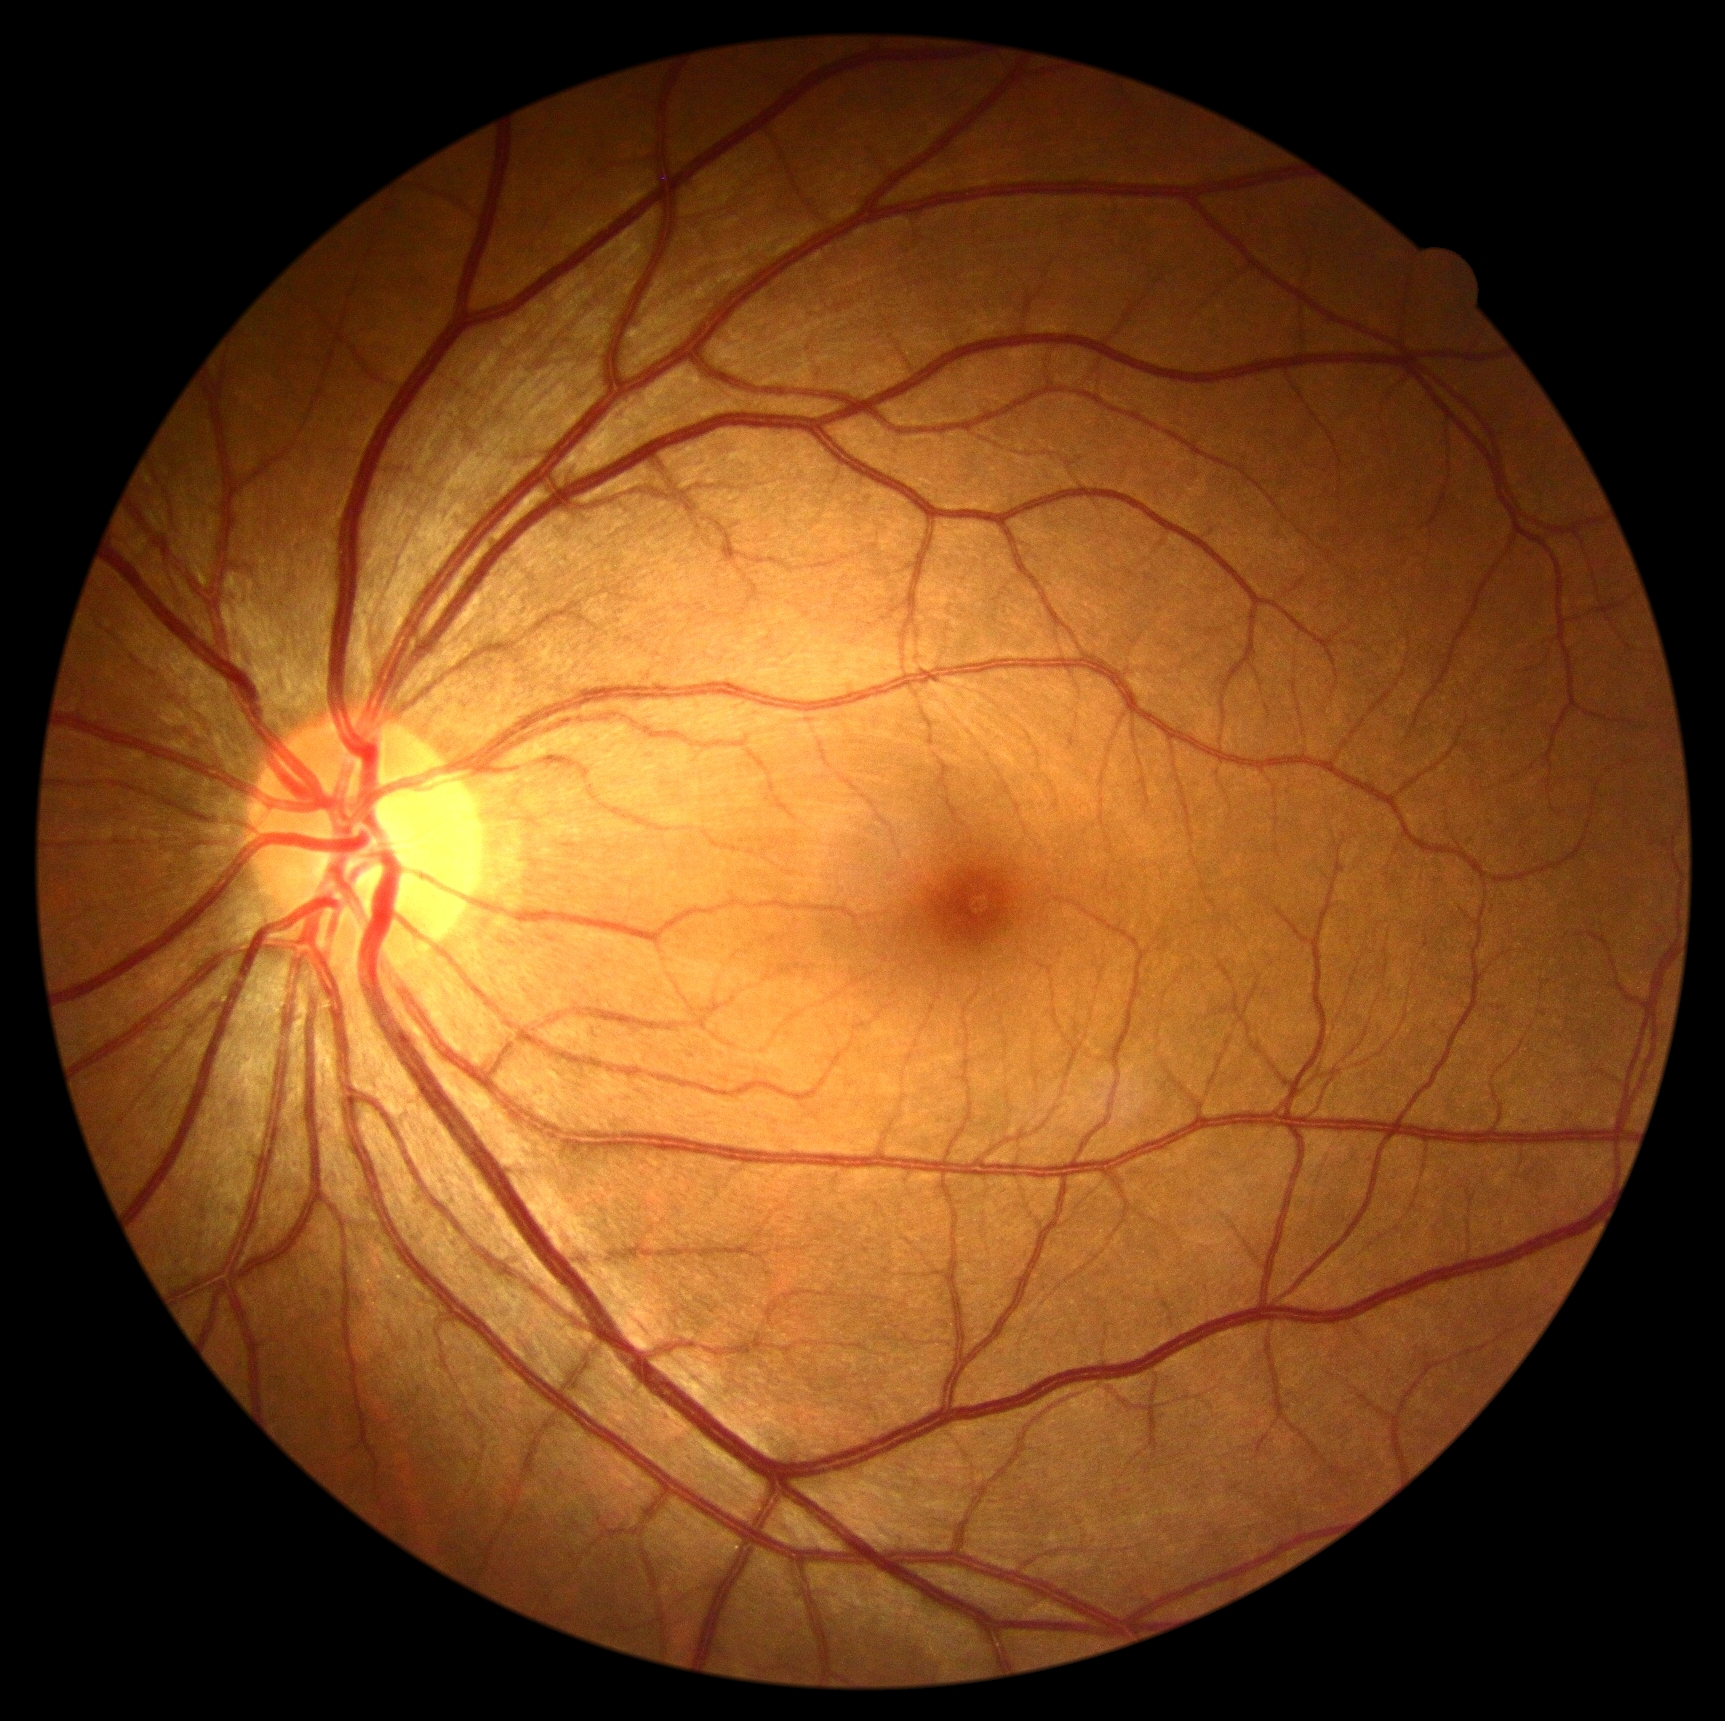

Findings:
* DR stage — grade 0
* DR impression — no signs of DR